Image size 1240x1240 · Phoenix ICON wide-field infant fundus image.
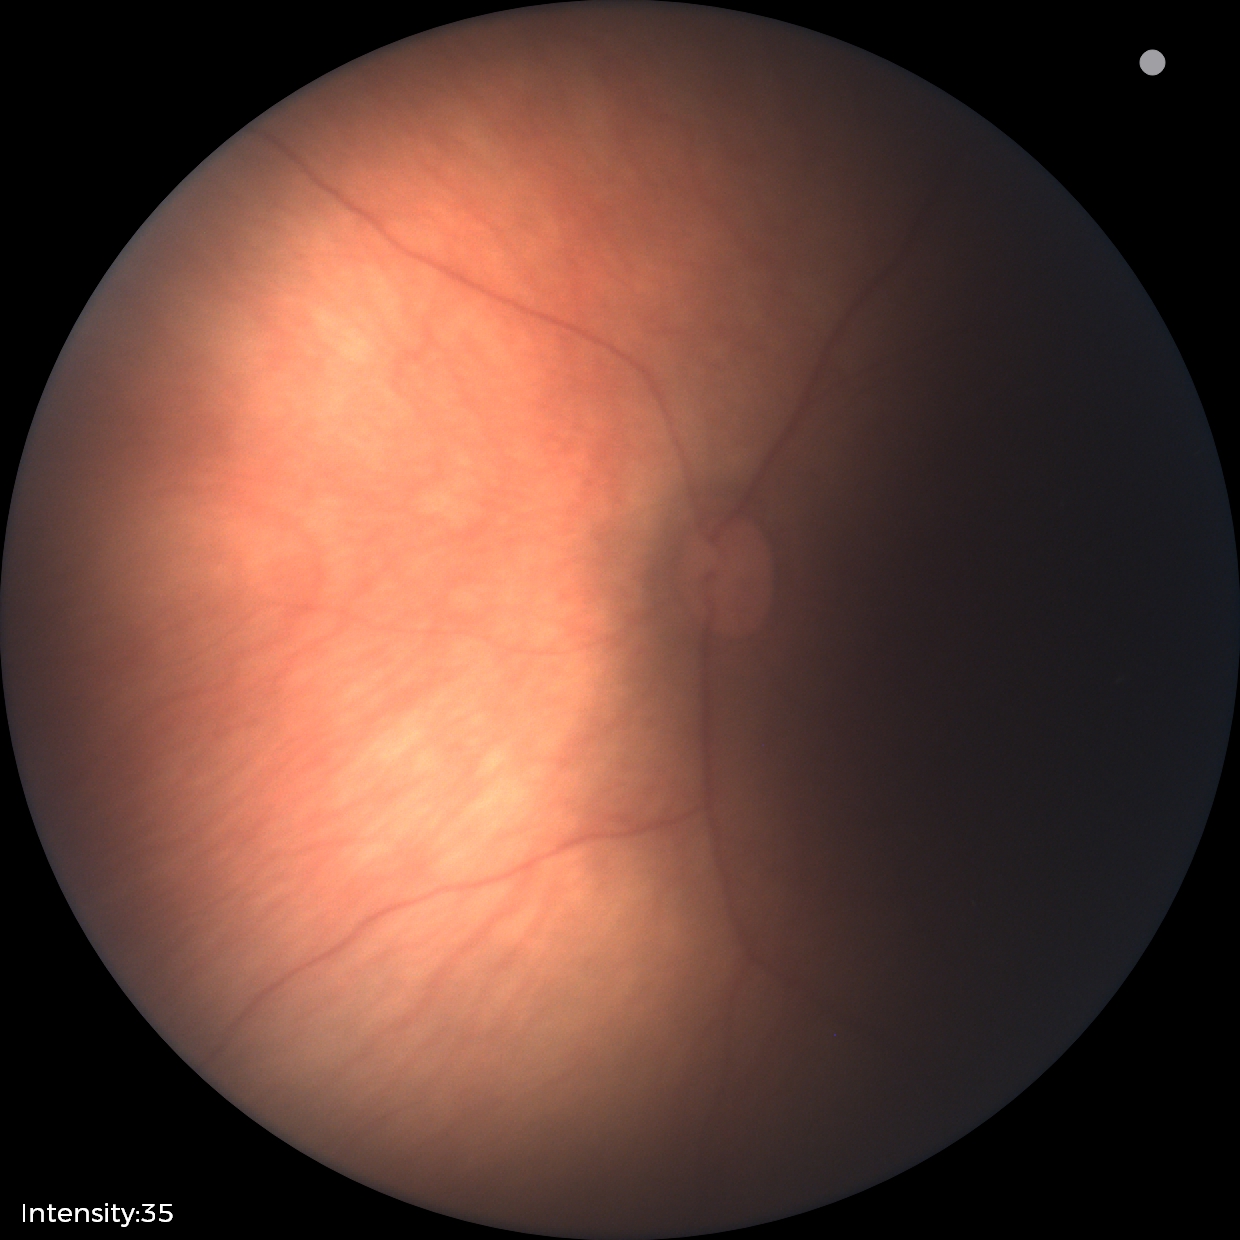 Q: What is the screening diagnosis?
A: physiological retinal finding